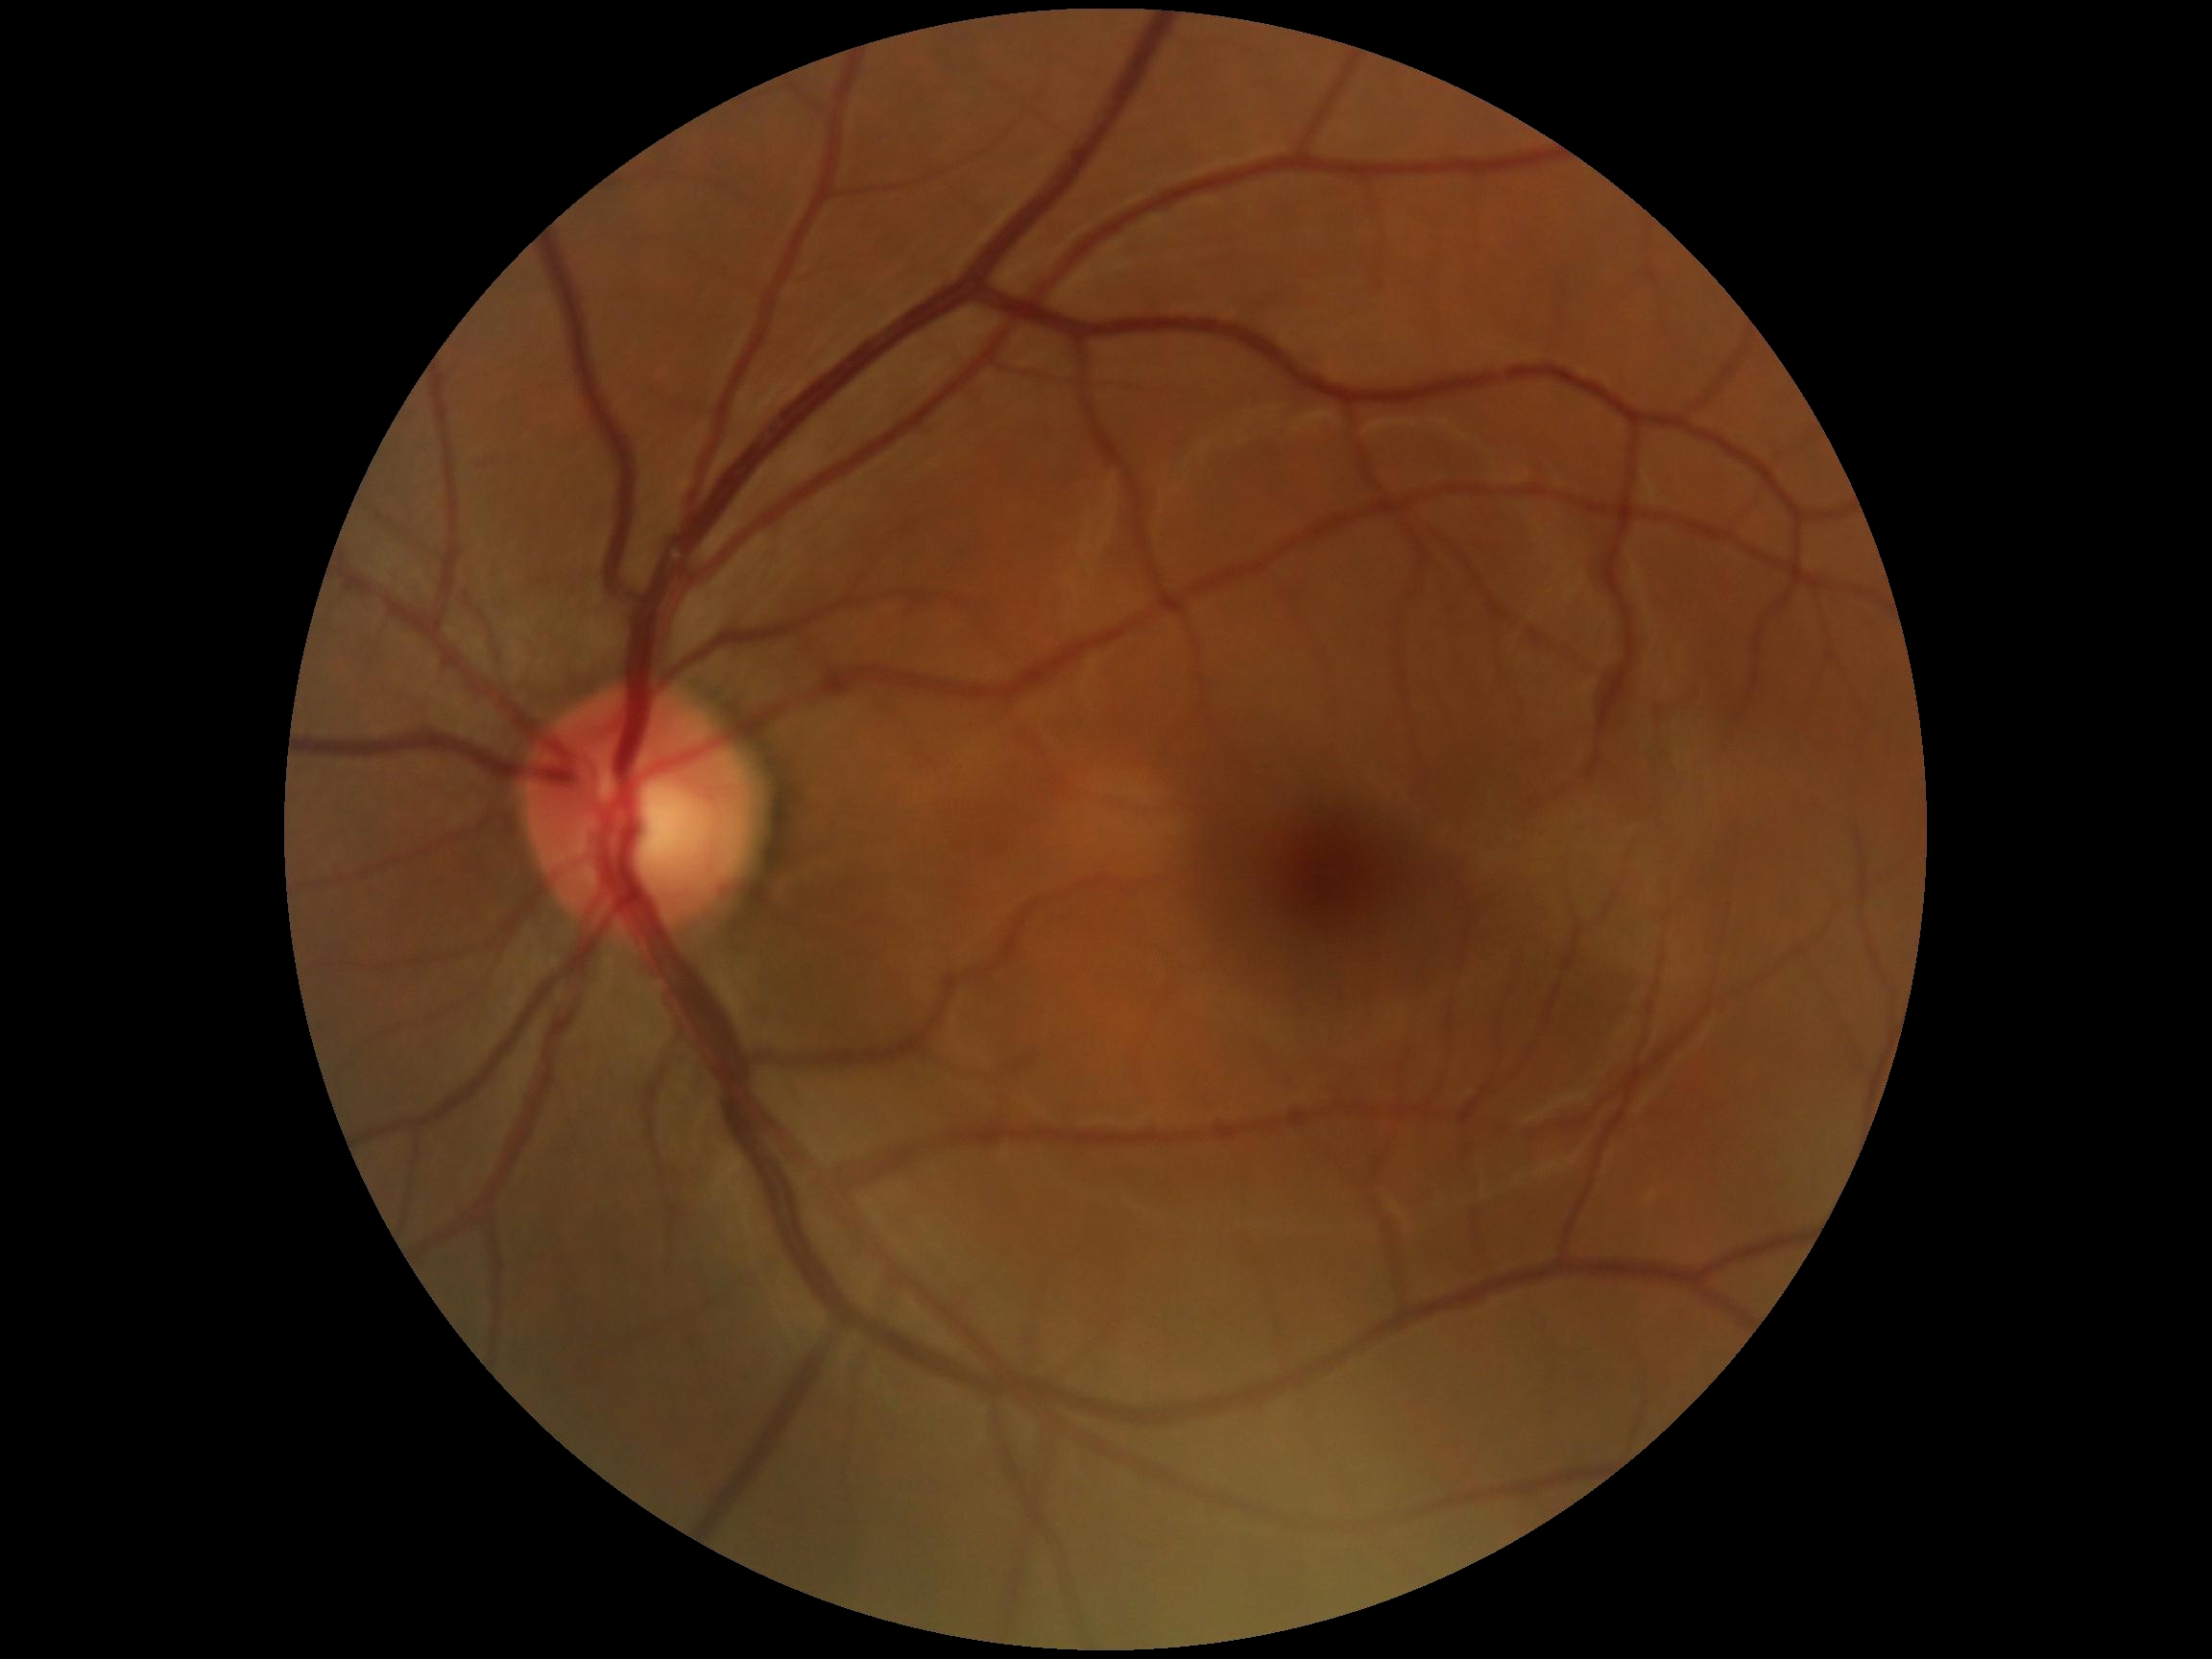 dr_impression: negative for DR
dr_grade: 0